1932x1910; 45-degree field of view
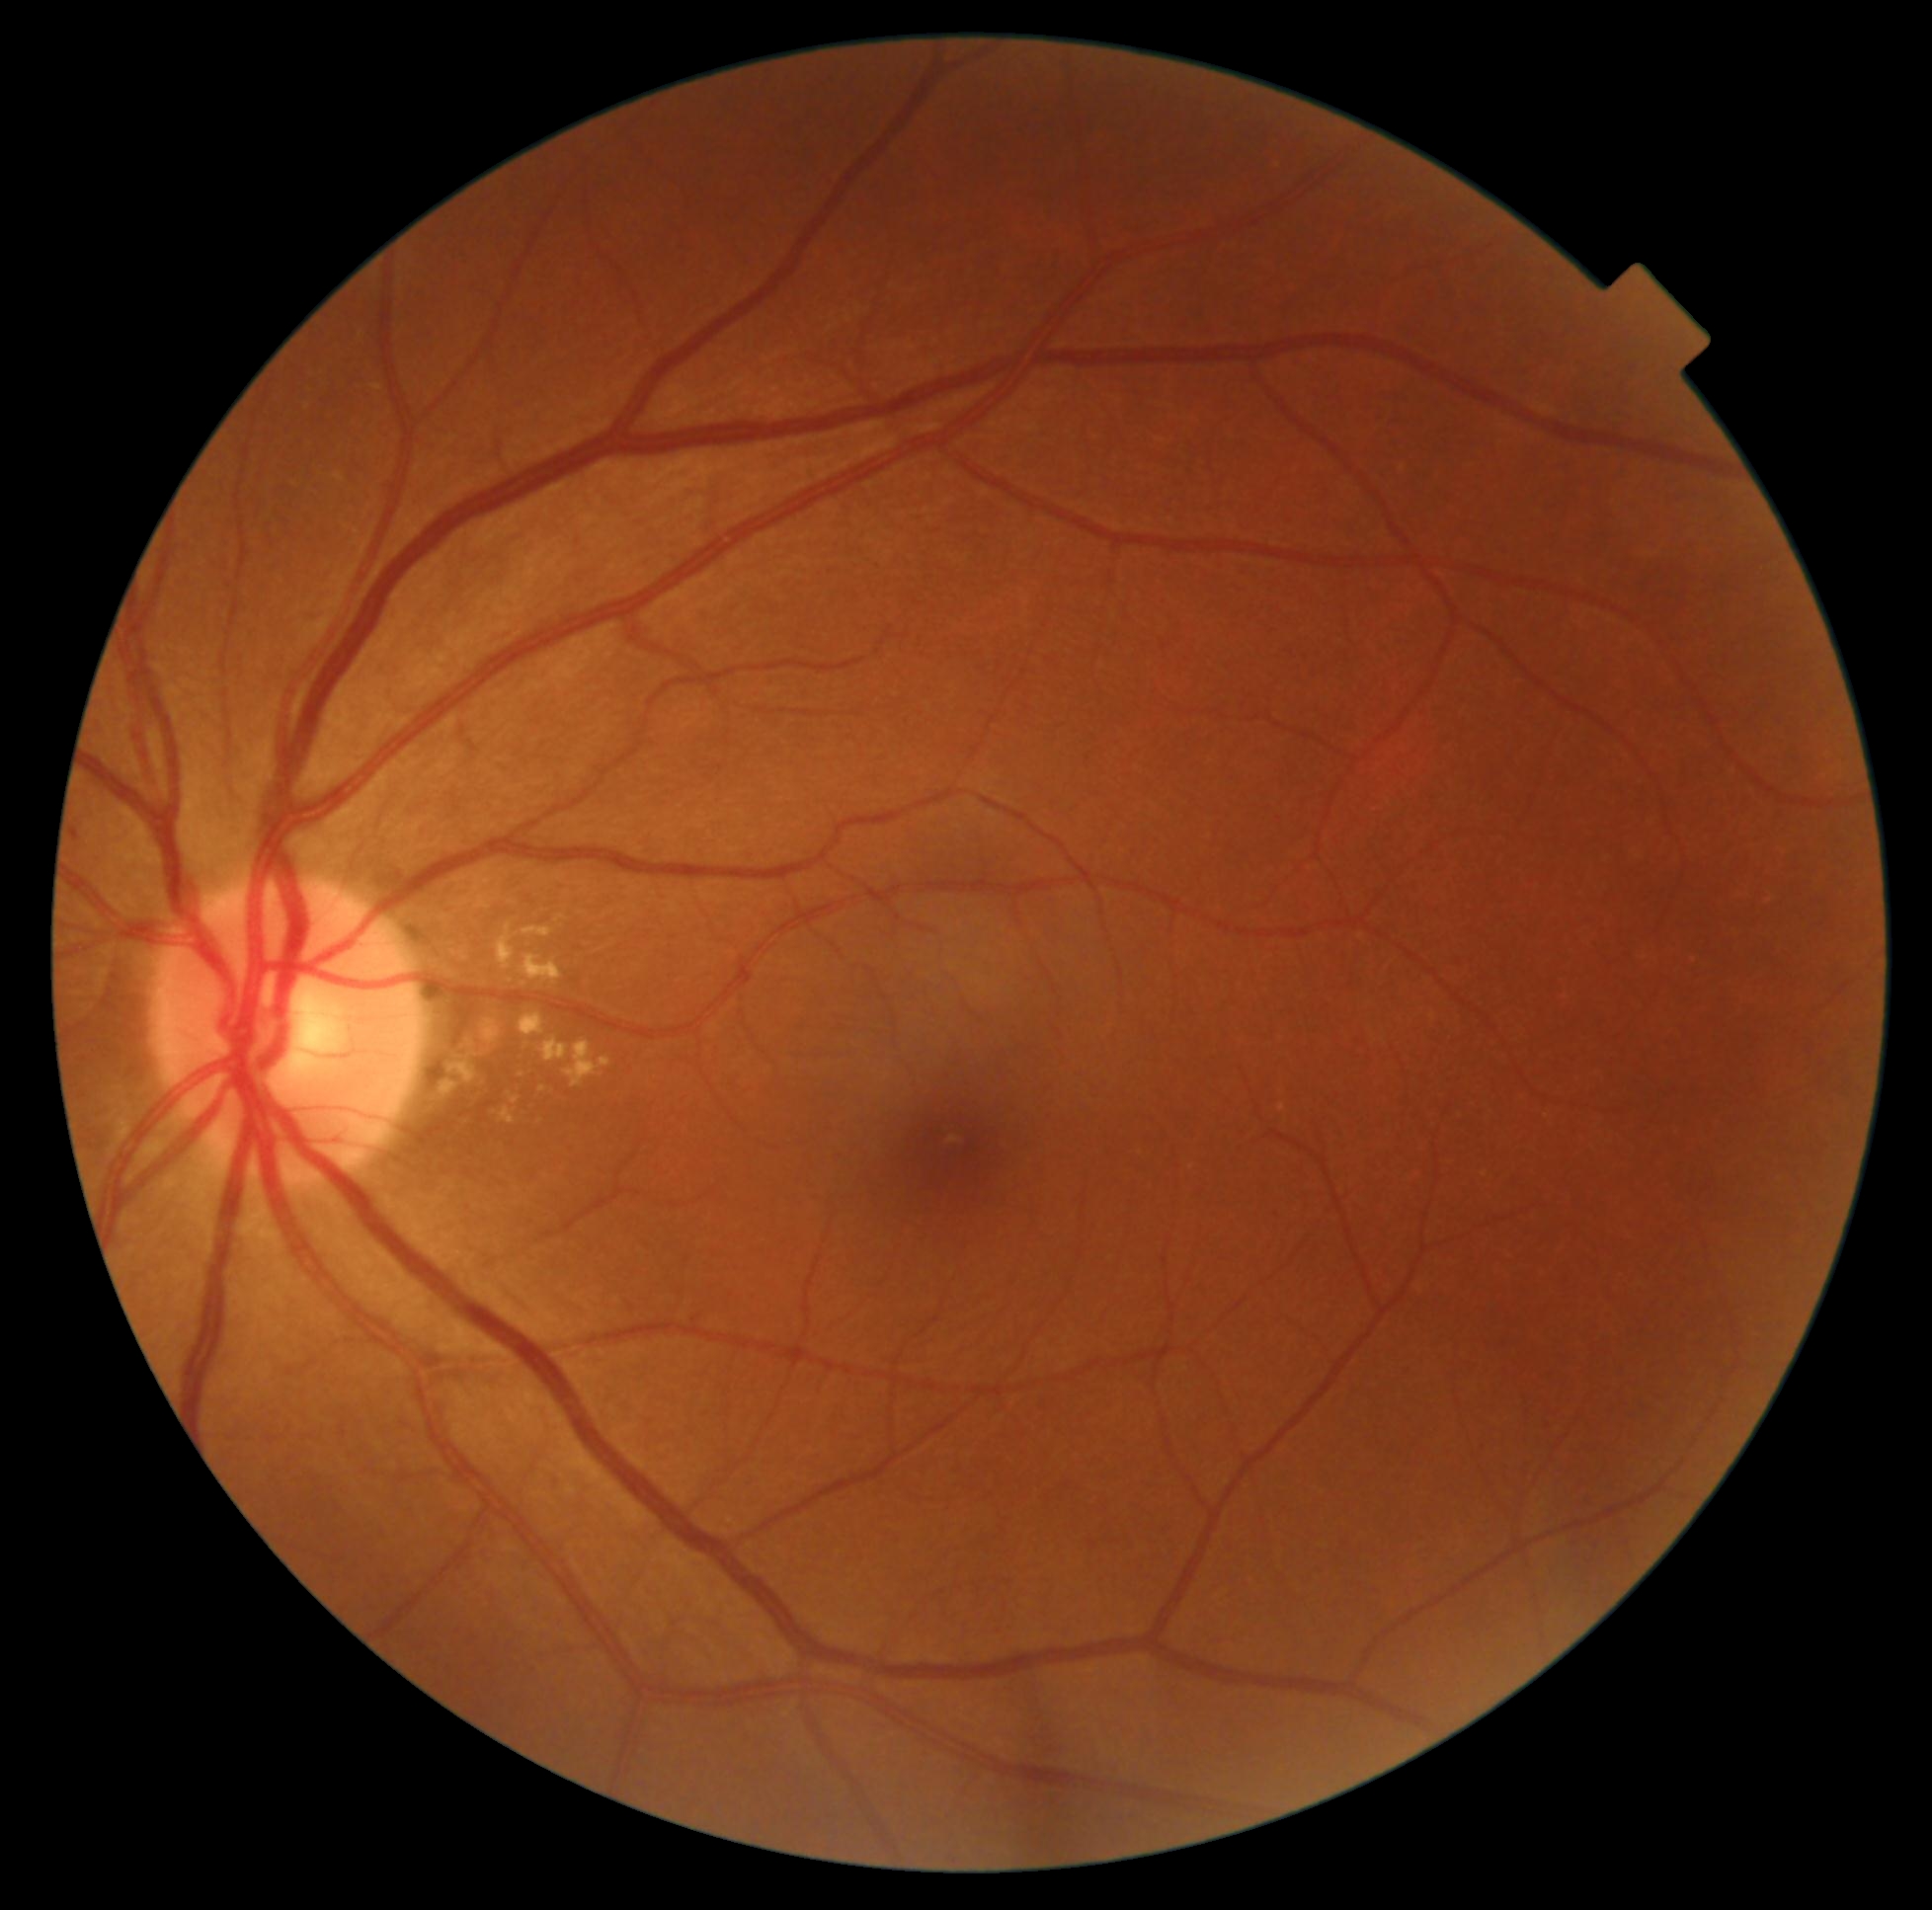

DR severity=grade 2 (moderate NPDR).